Wide-field fundus photograph from neonatal ROP screening
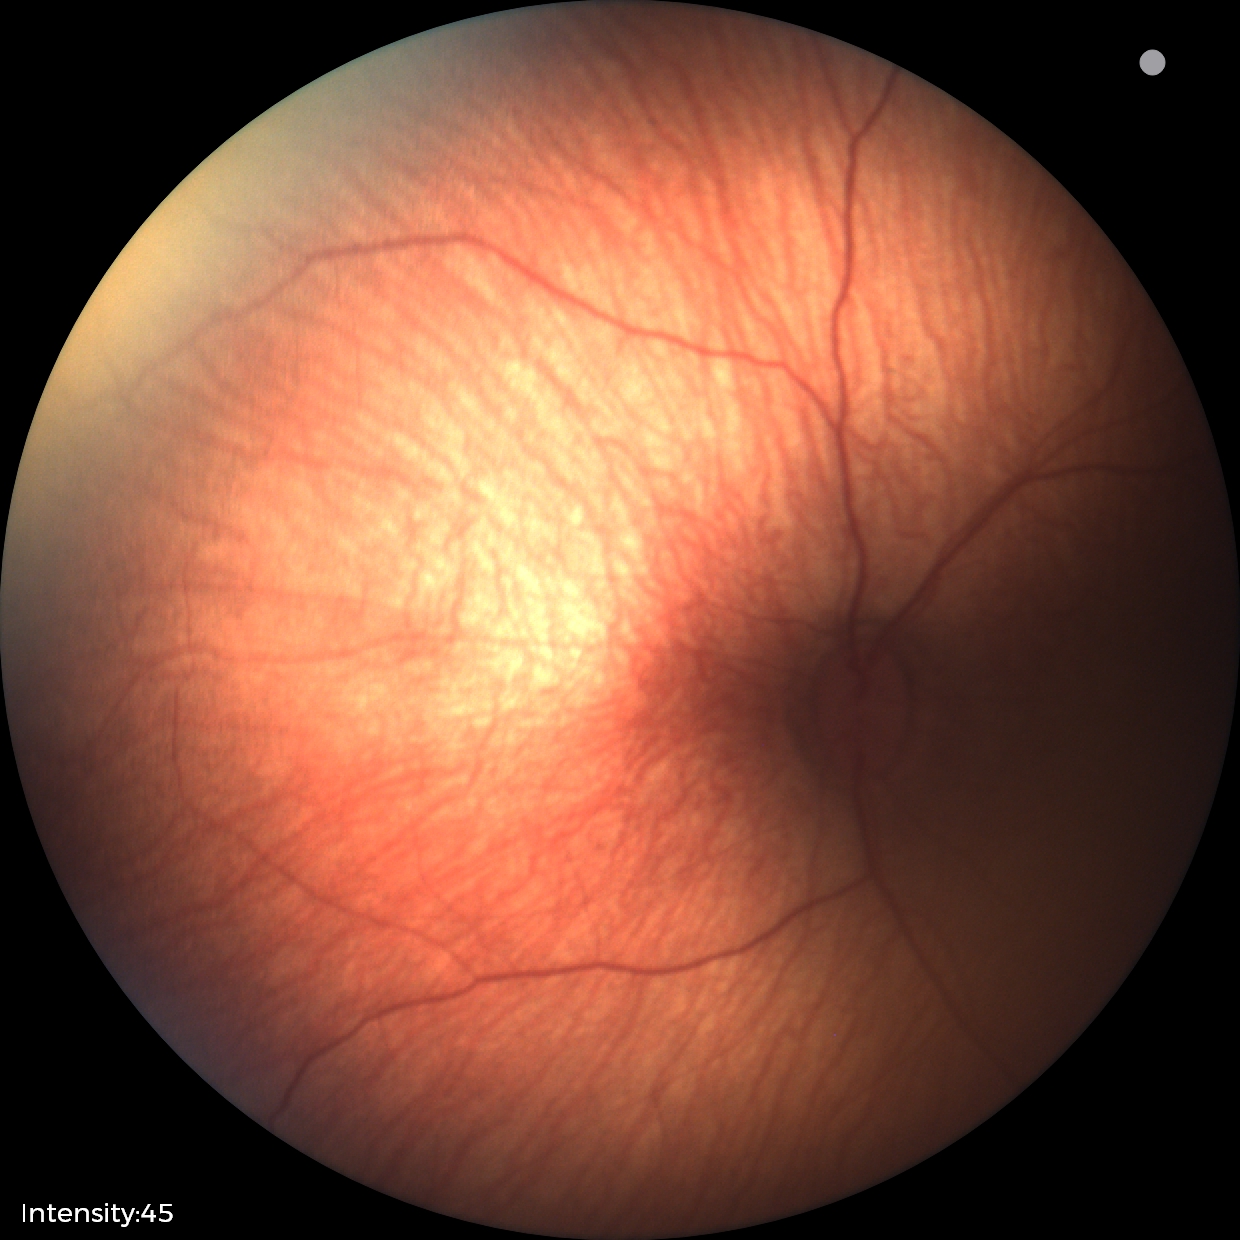 Impression = status post ROP.